Disc-centered fundus crop:
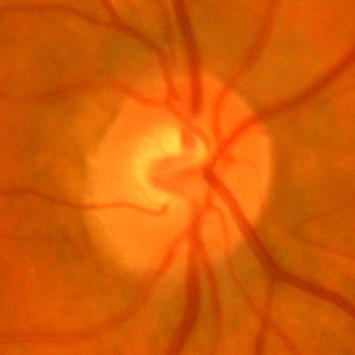

Q: Is there glaucomatous optic neuropathy?
A: No glaucomatous changes.